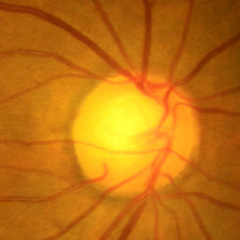

The image shows no evidence of glaucoma.